Infant wide-field retinal image; 640 by 480 pixels:
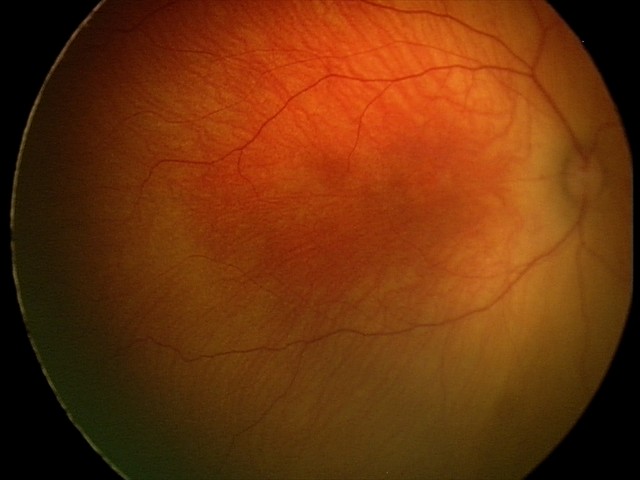

Screening: physiological appearance with no retinal pathology.